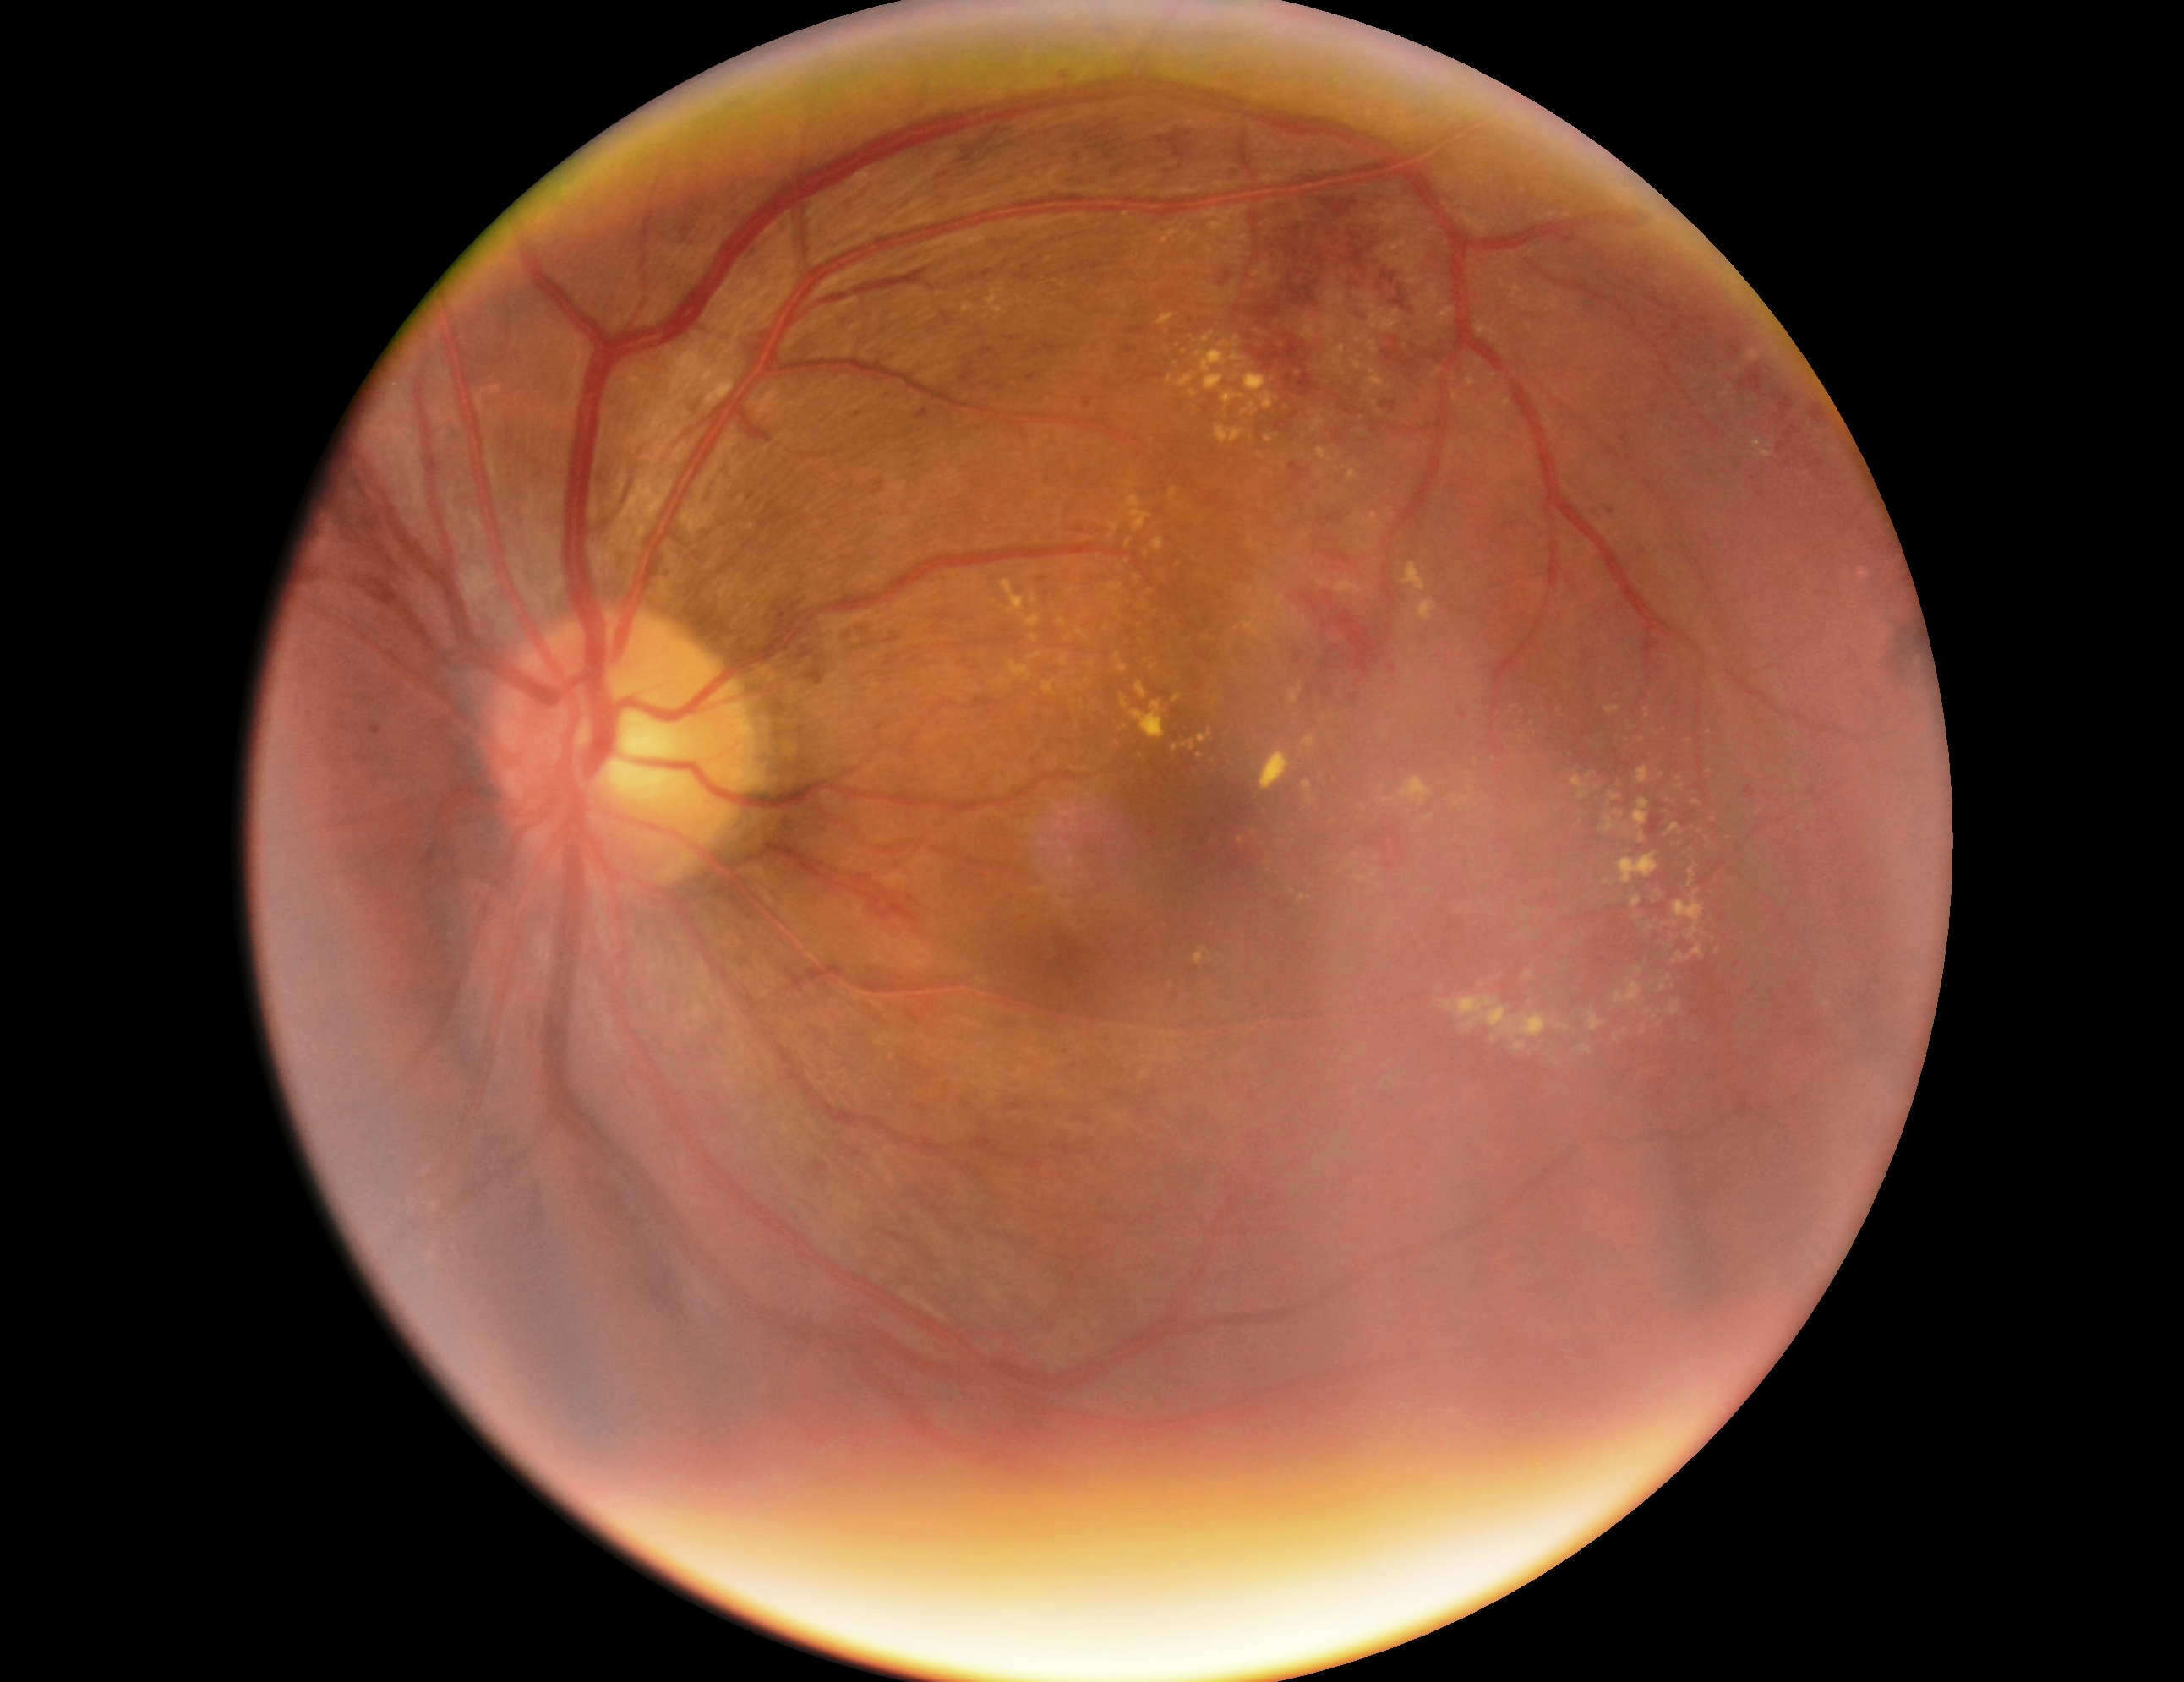

{"dr_grade": "moderate NPDR (grade 2)"}